2346 x 1568 pixels; fundus photo: 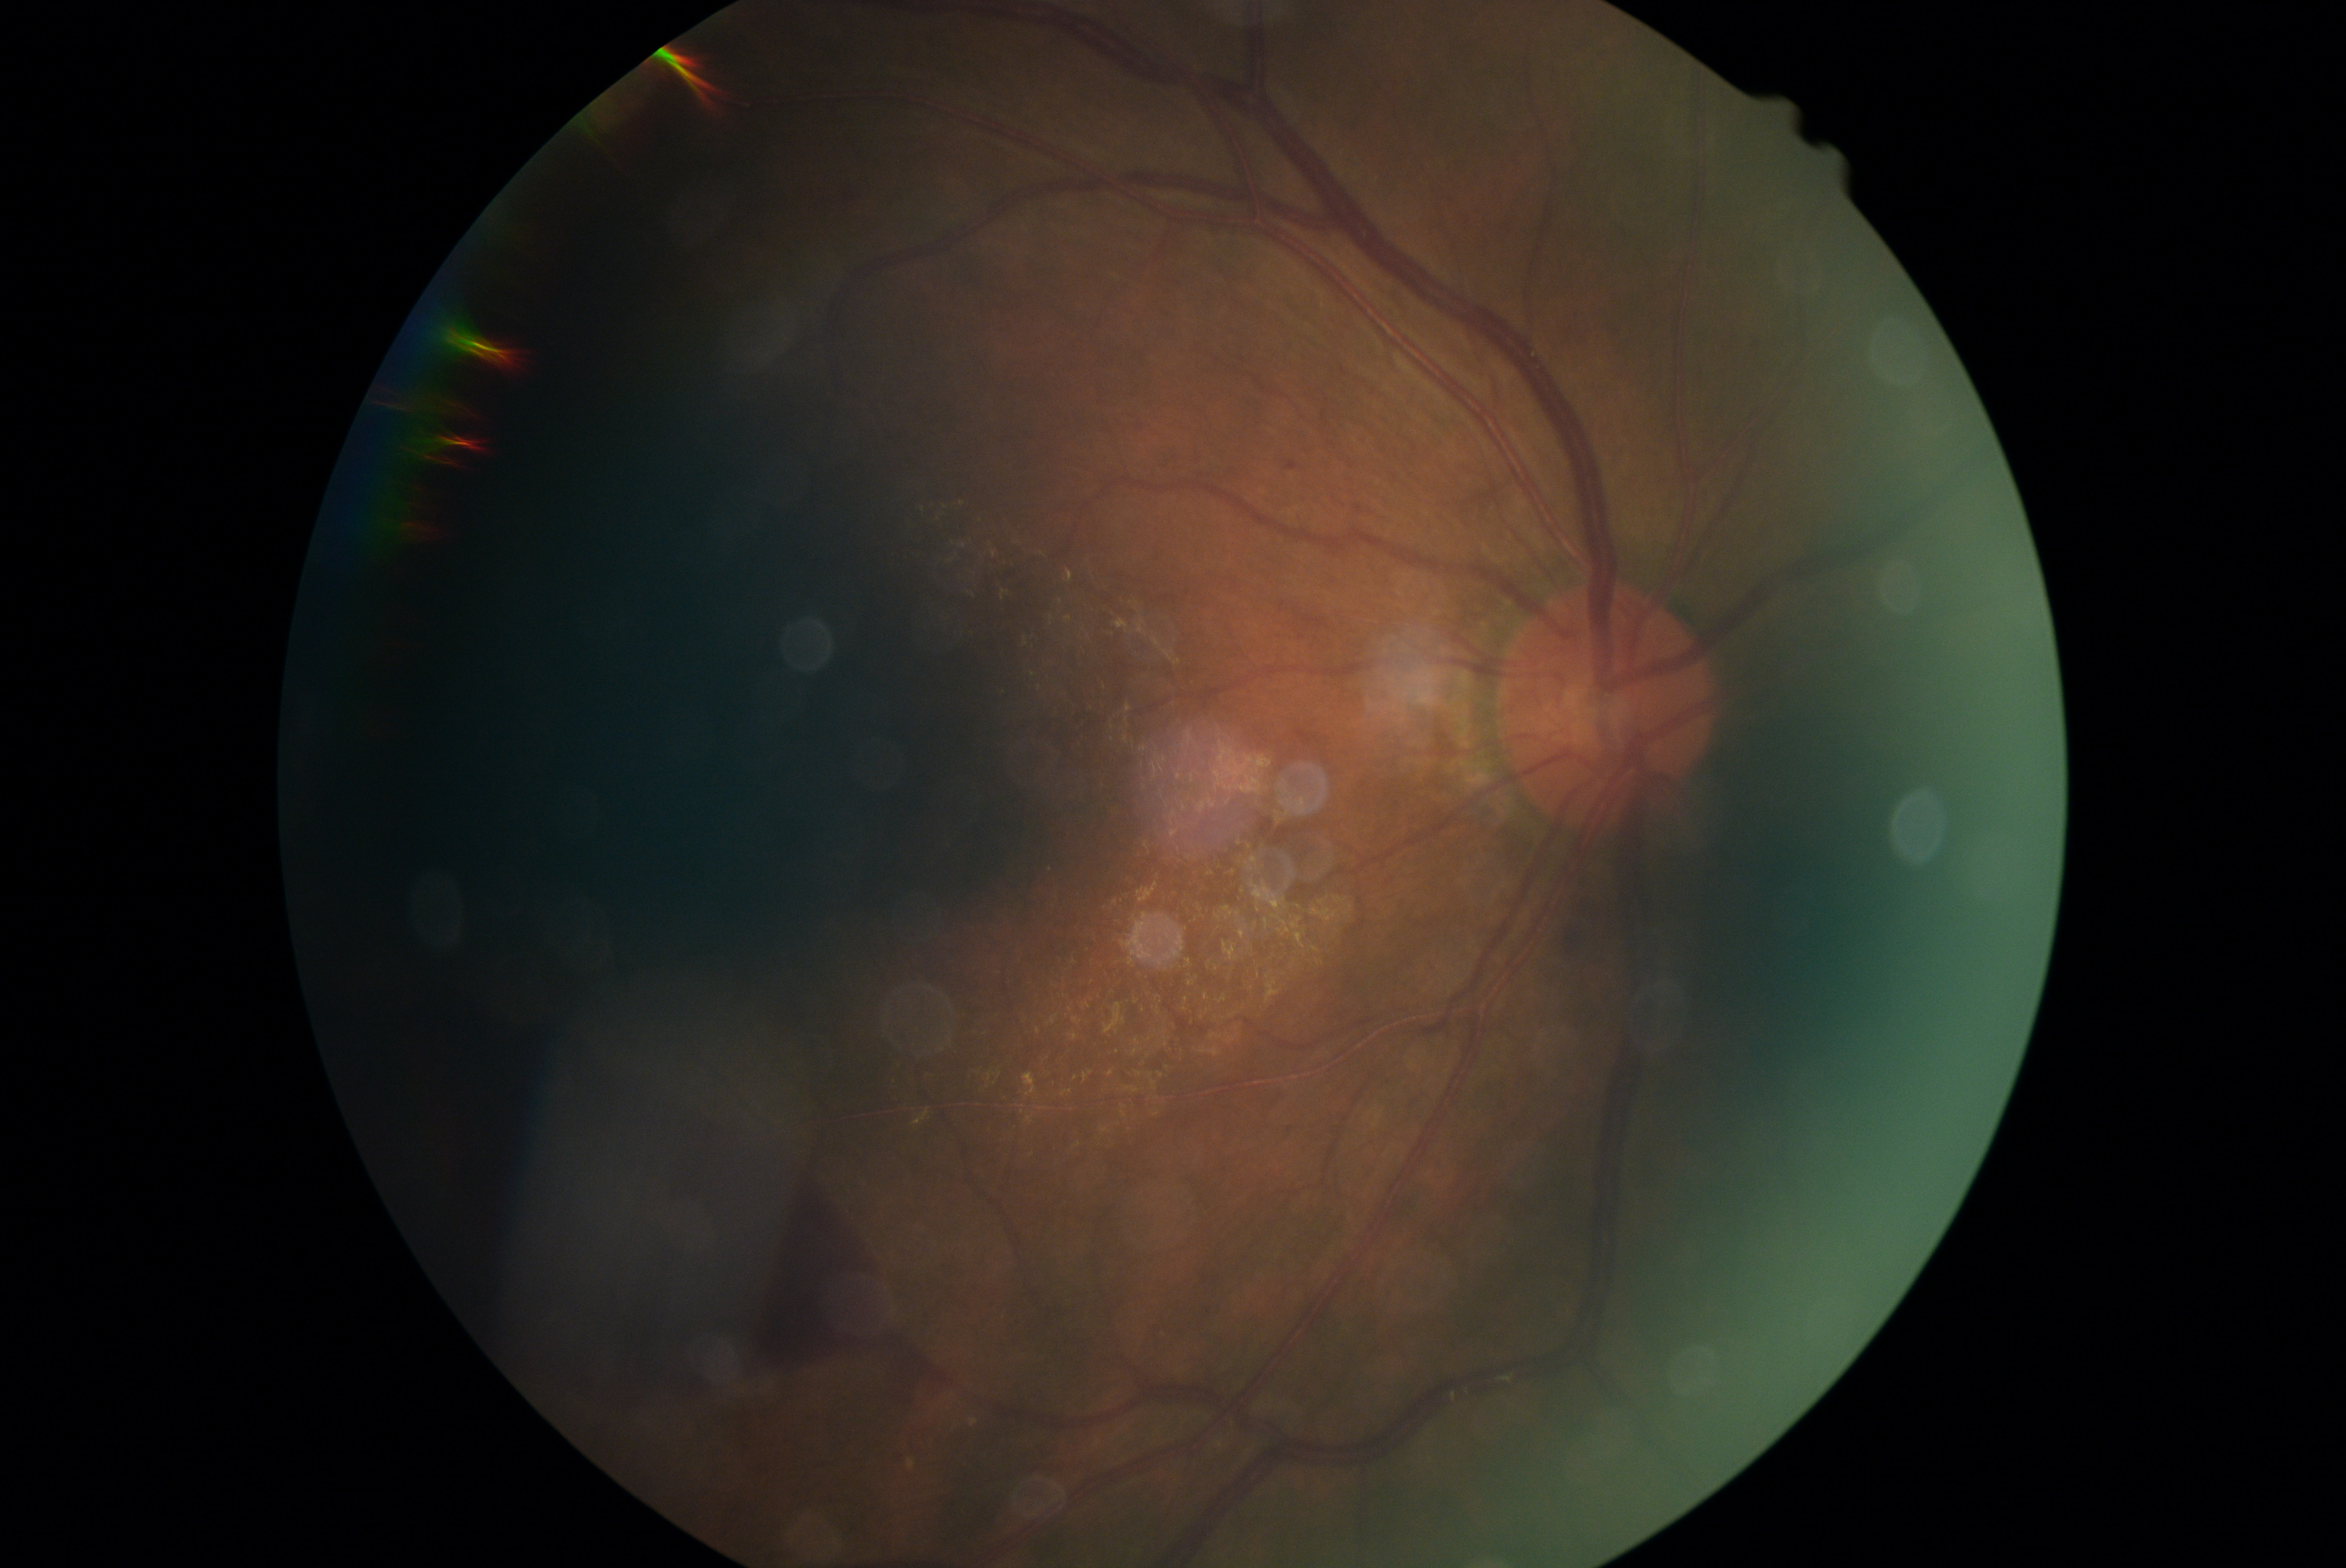
Retinopathy grade: 4 (PDR).